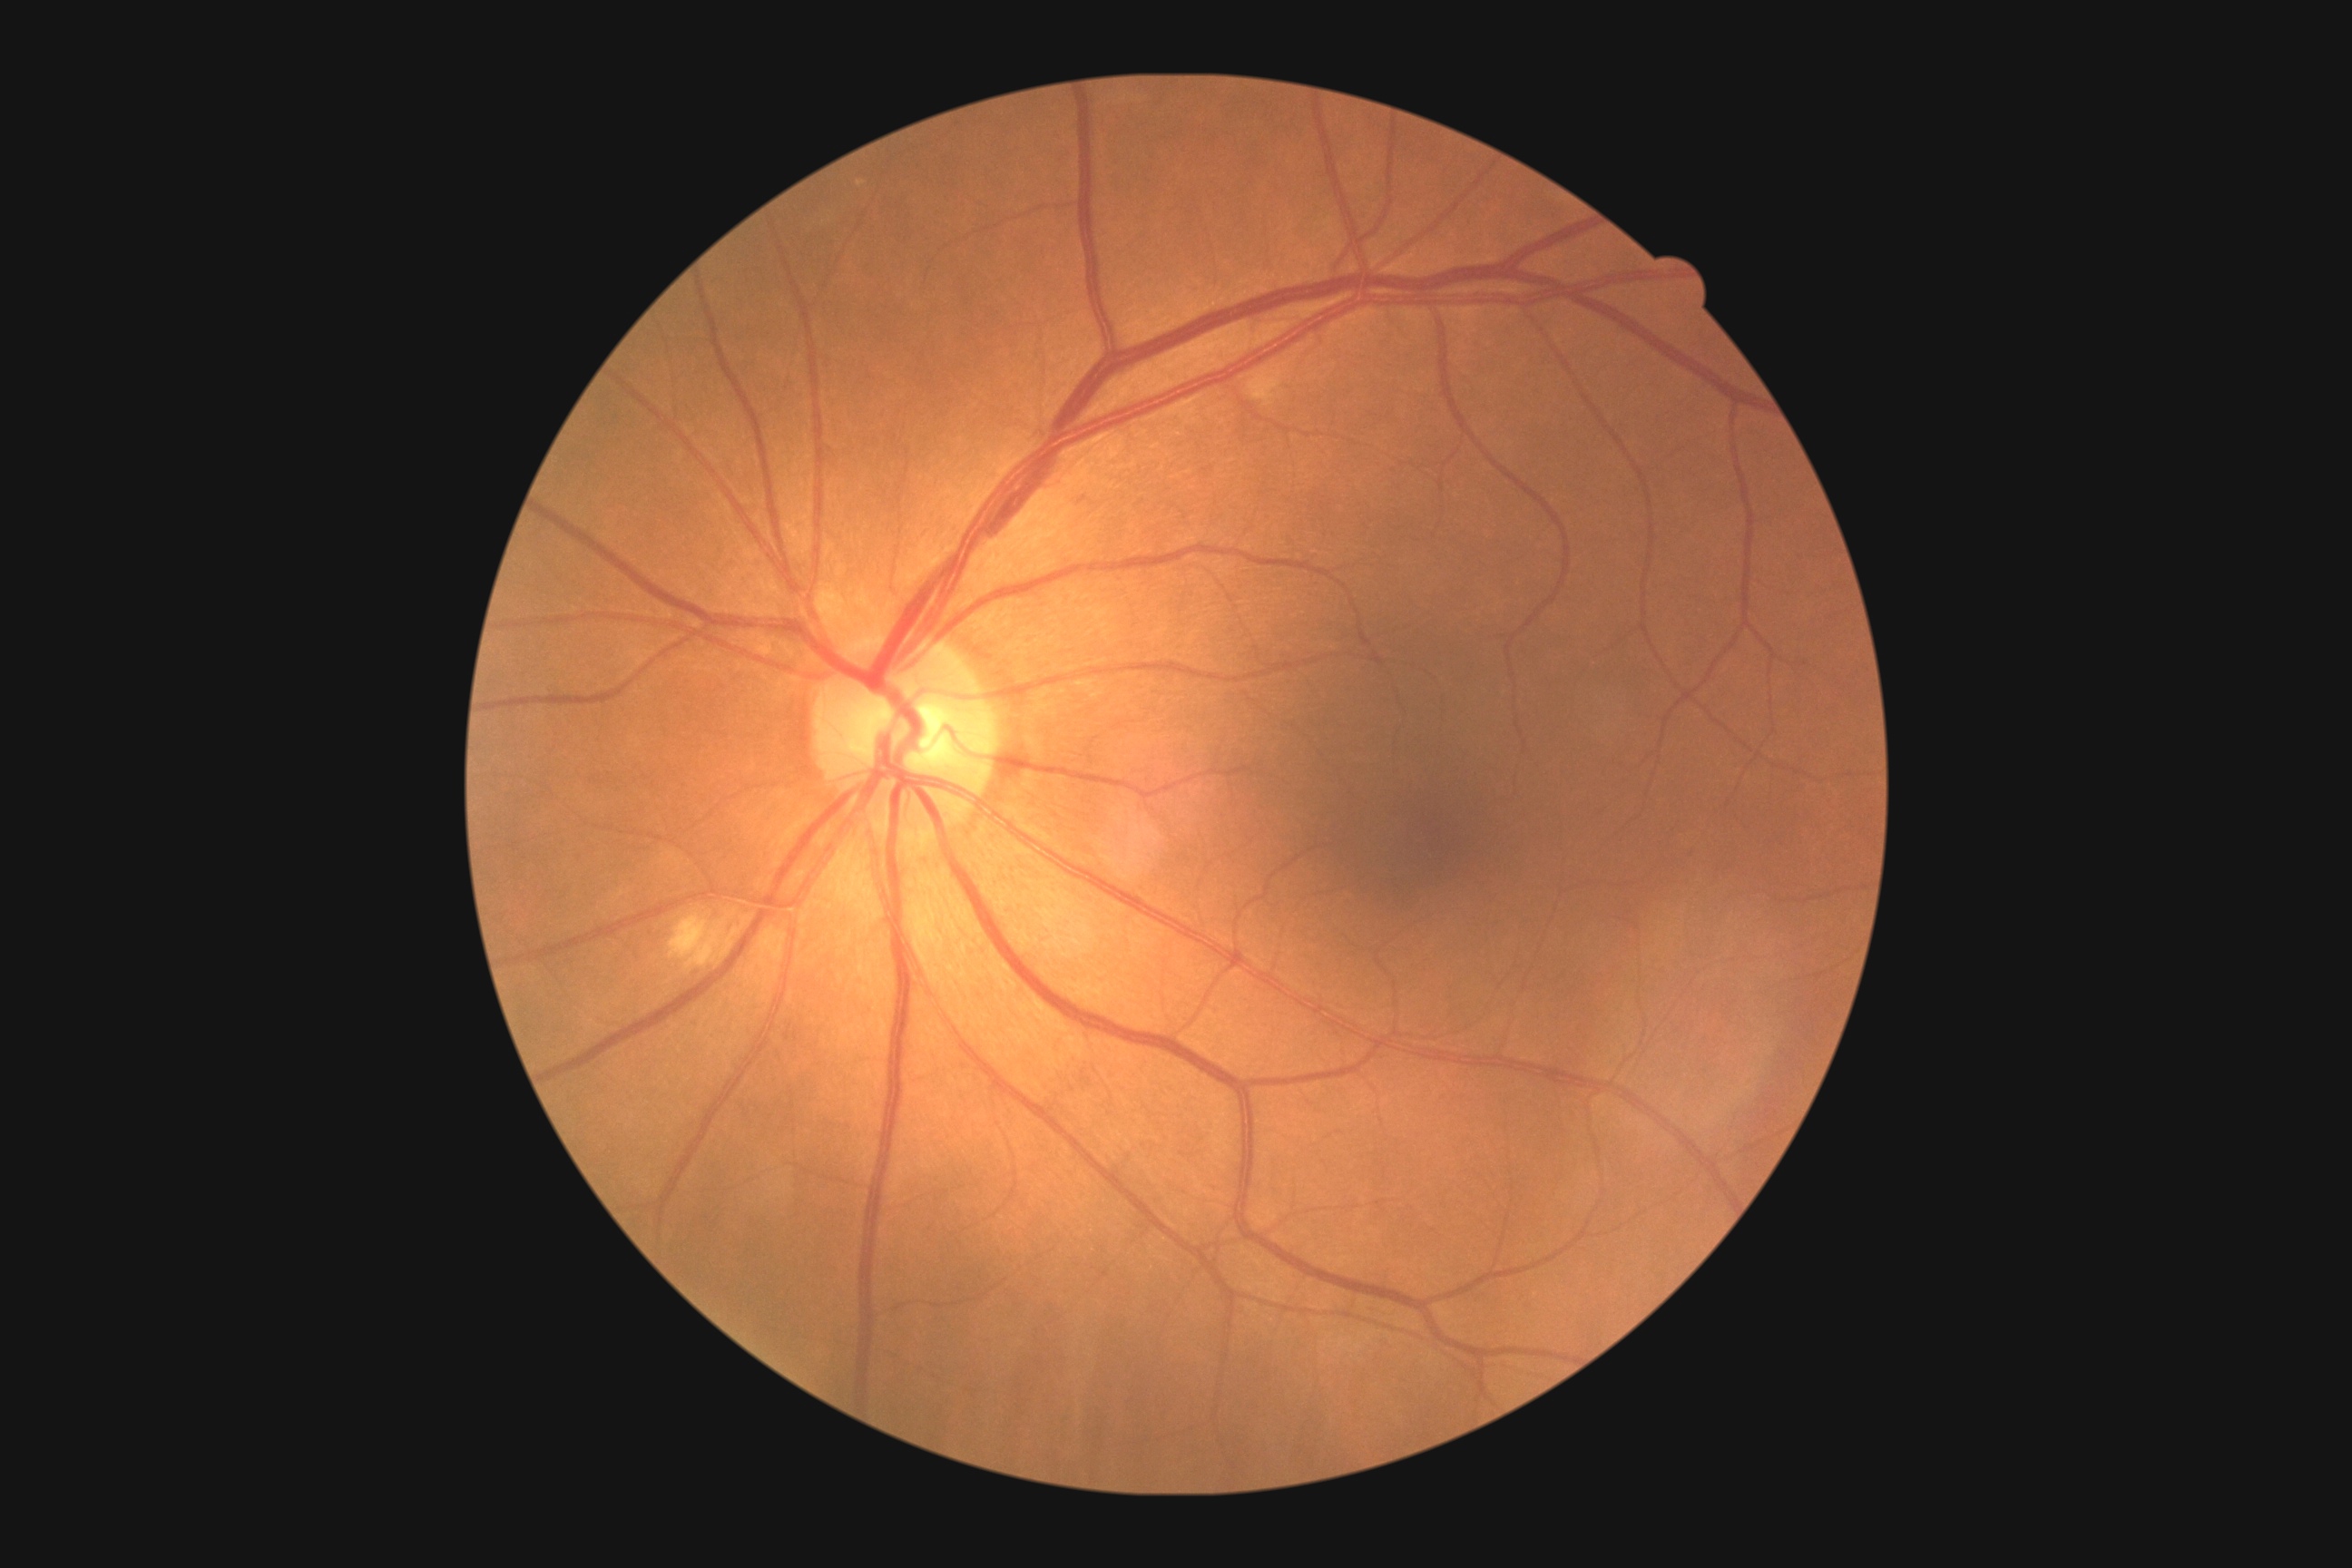

DR stage = grade 2